CFP. Modified Davis classification. No pharmacologic dilation. 45° field of view. Acquired with a NIDEK AFC-230. 848 by 848 pixels — 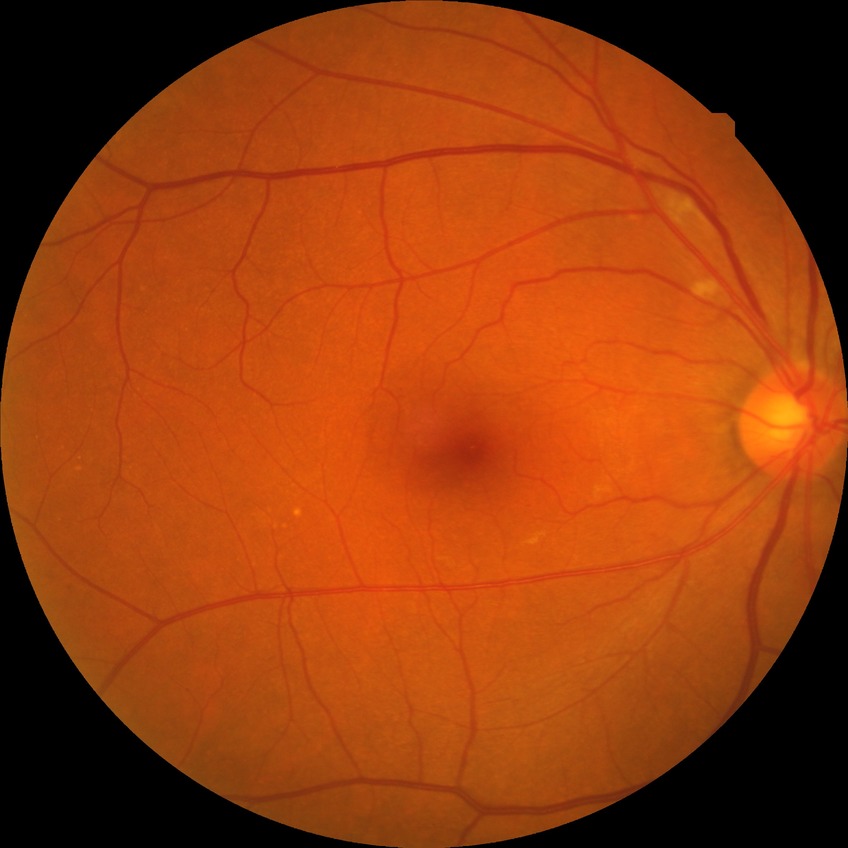 Diabetic retinopathy (DR) is SDR (simple diabetic retinopathy).